Without pupil dilation: 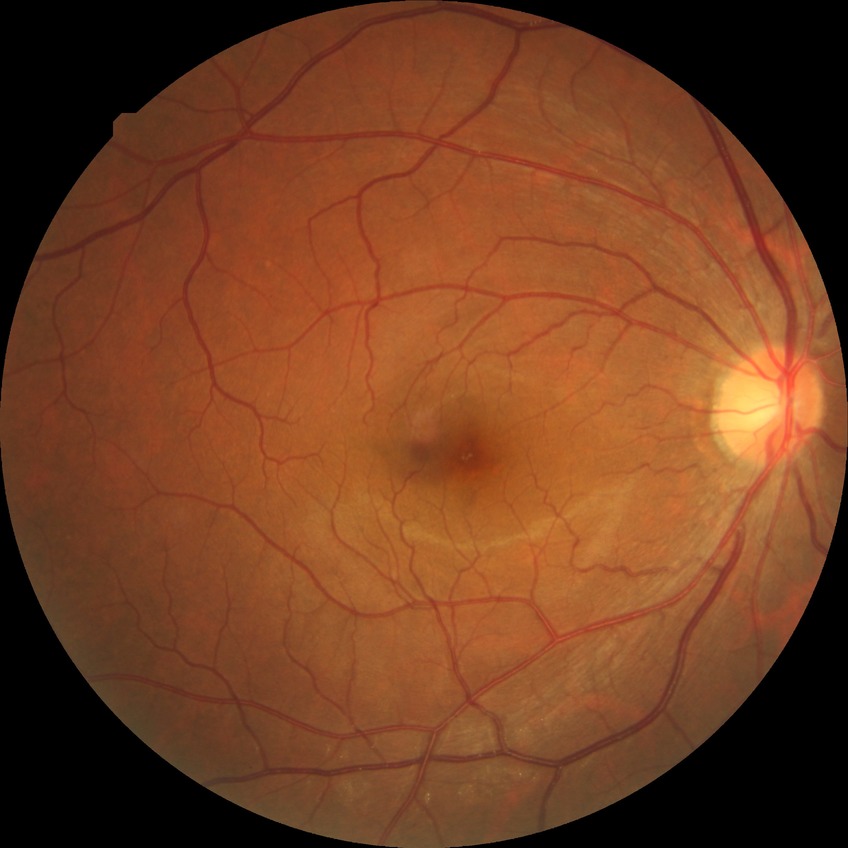 diabetic retinopathy (DR): NDR (no diabetic retinopathy)